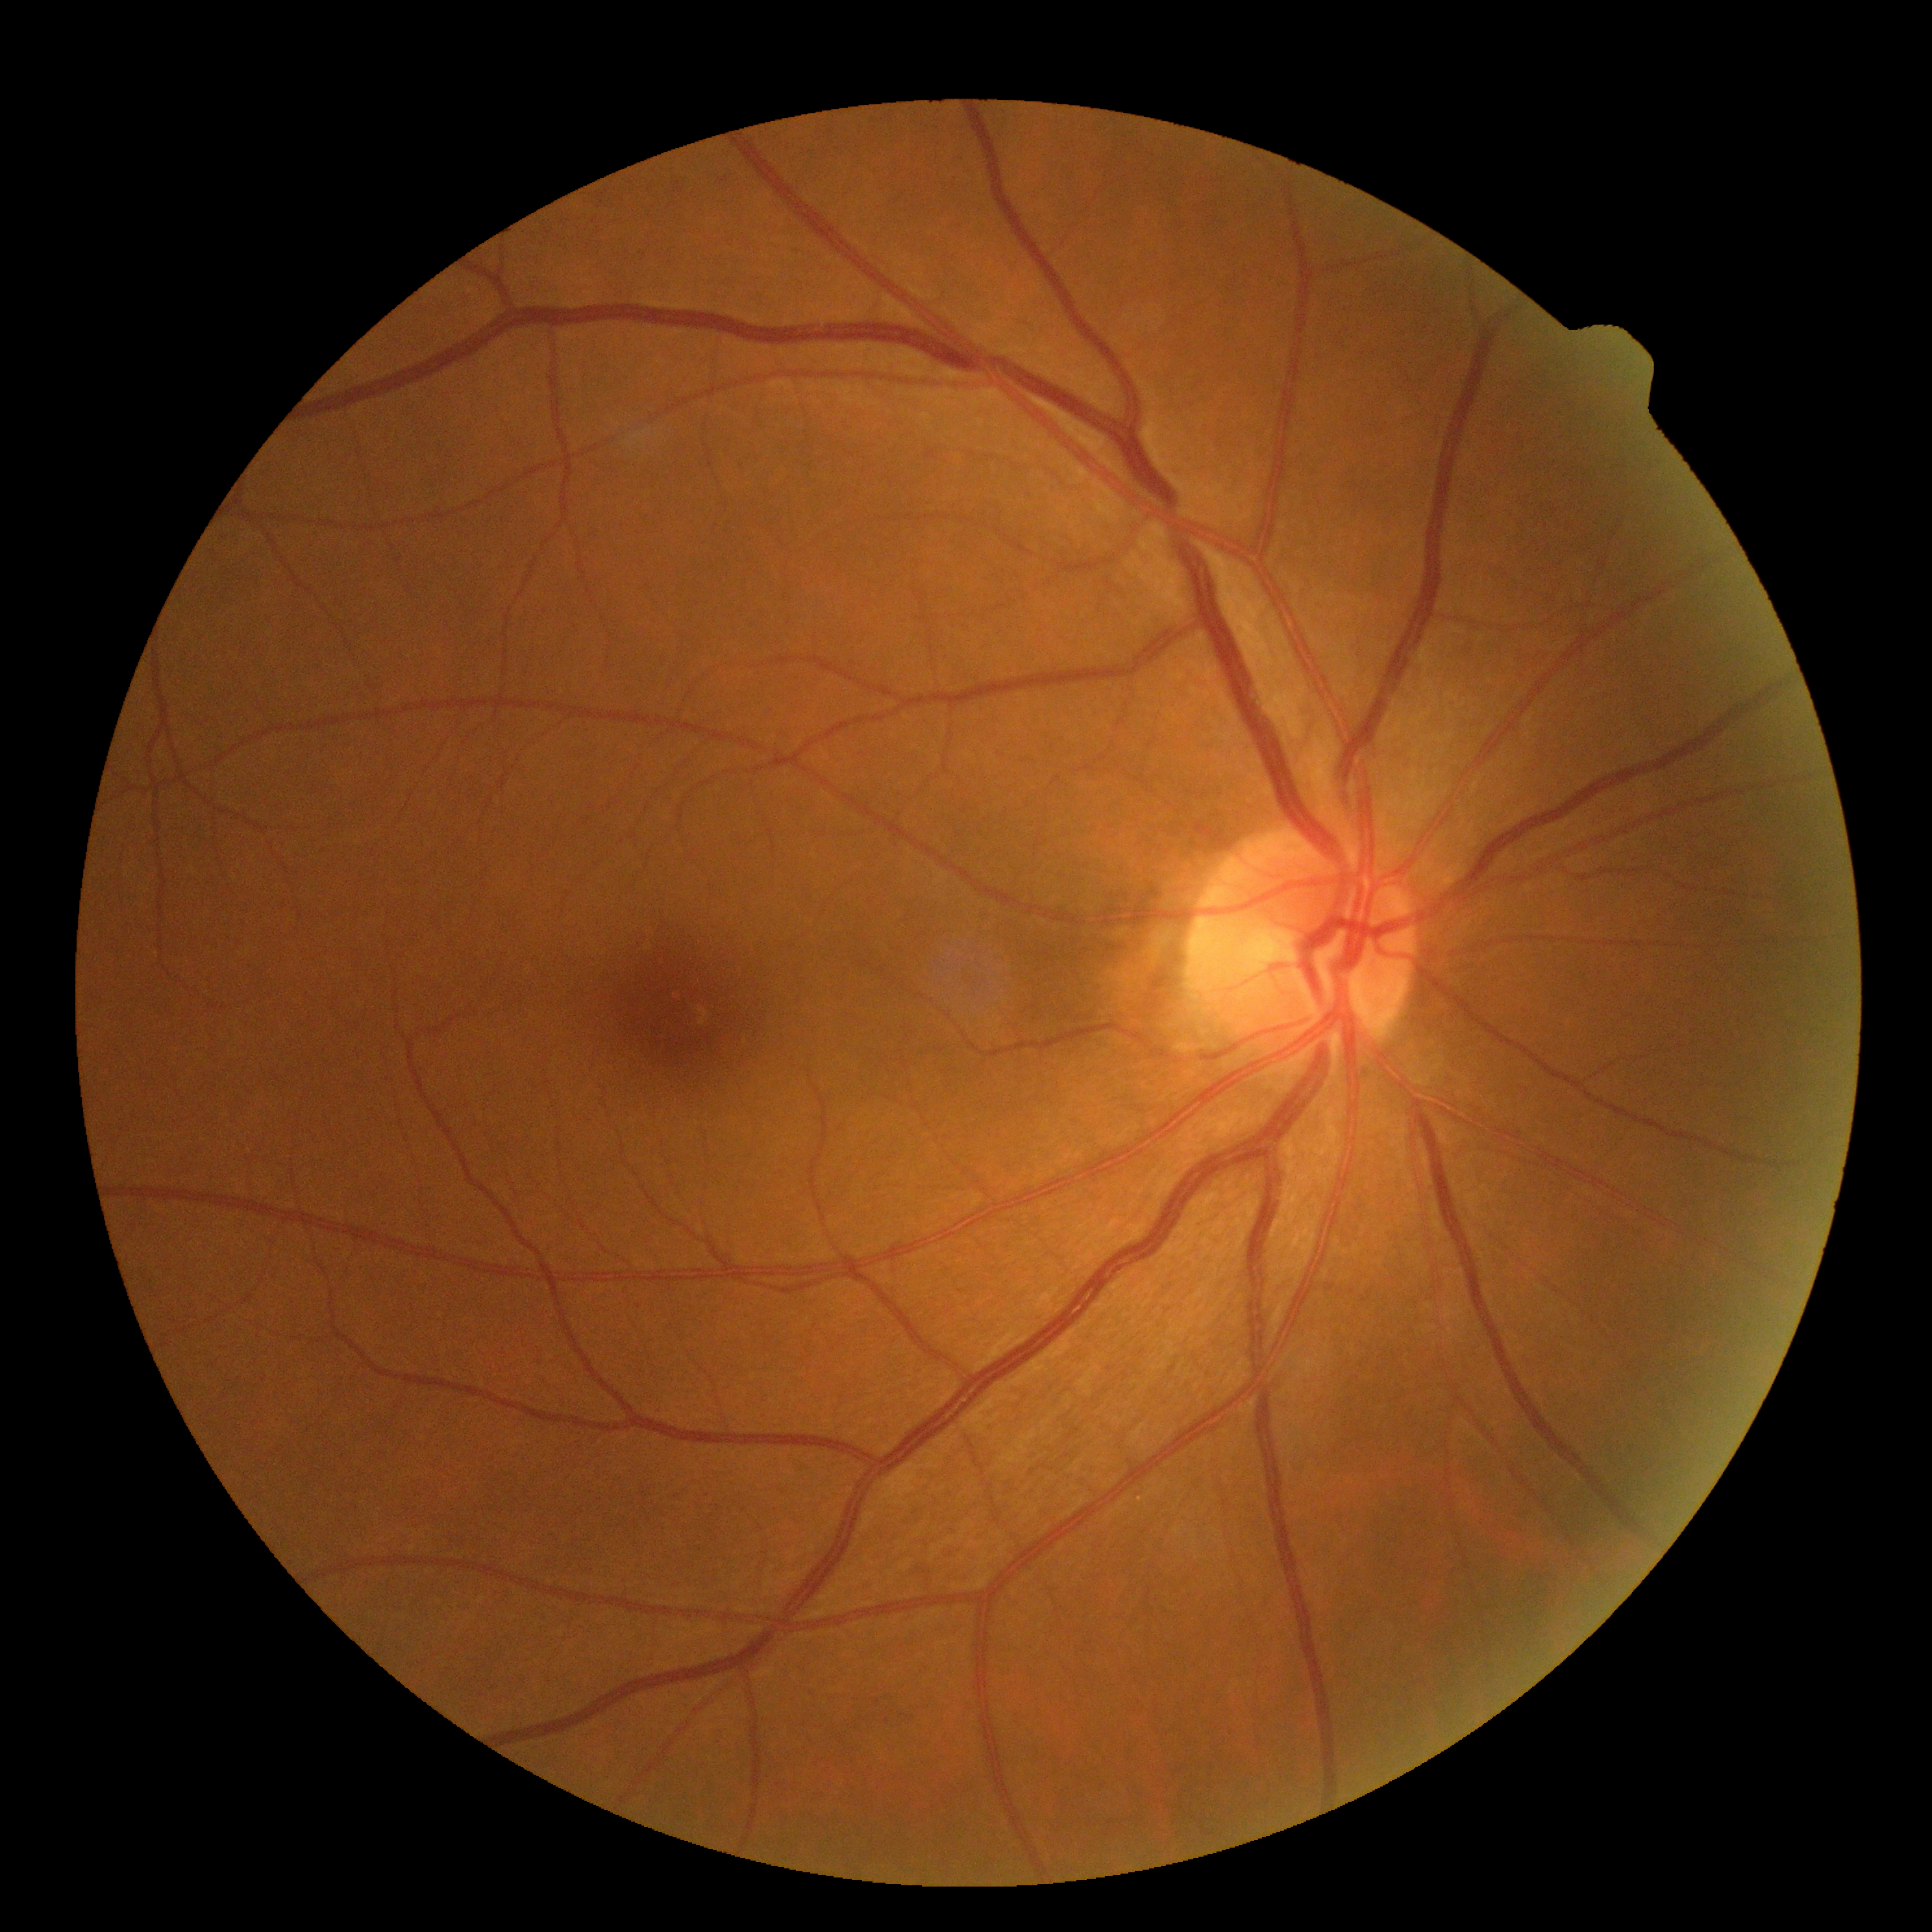
Diabetic retinopathy (DR): grade 0 (no apparent retinopathy).